1659x2212px; camera: Remidio smartphone fundus camera
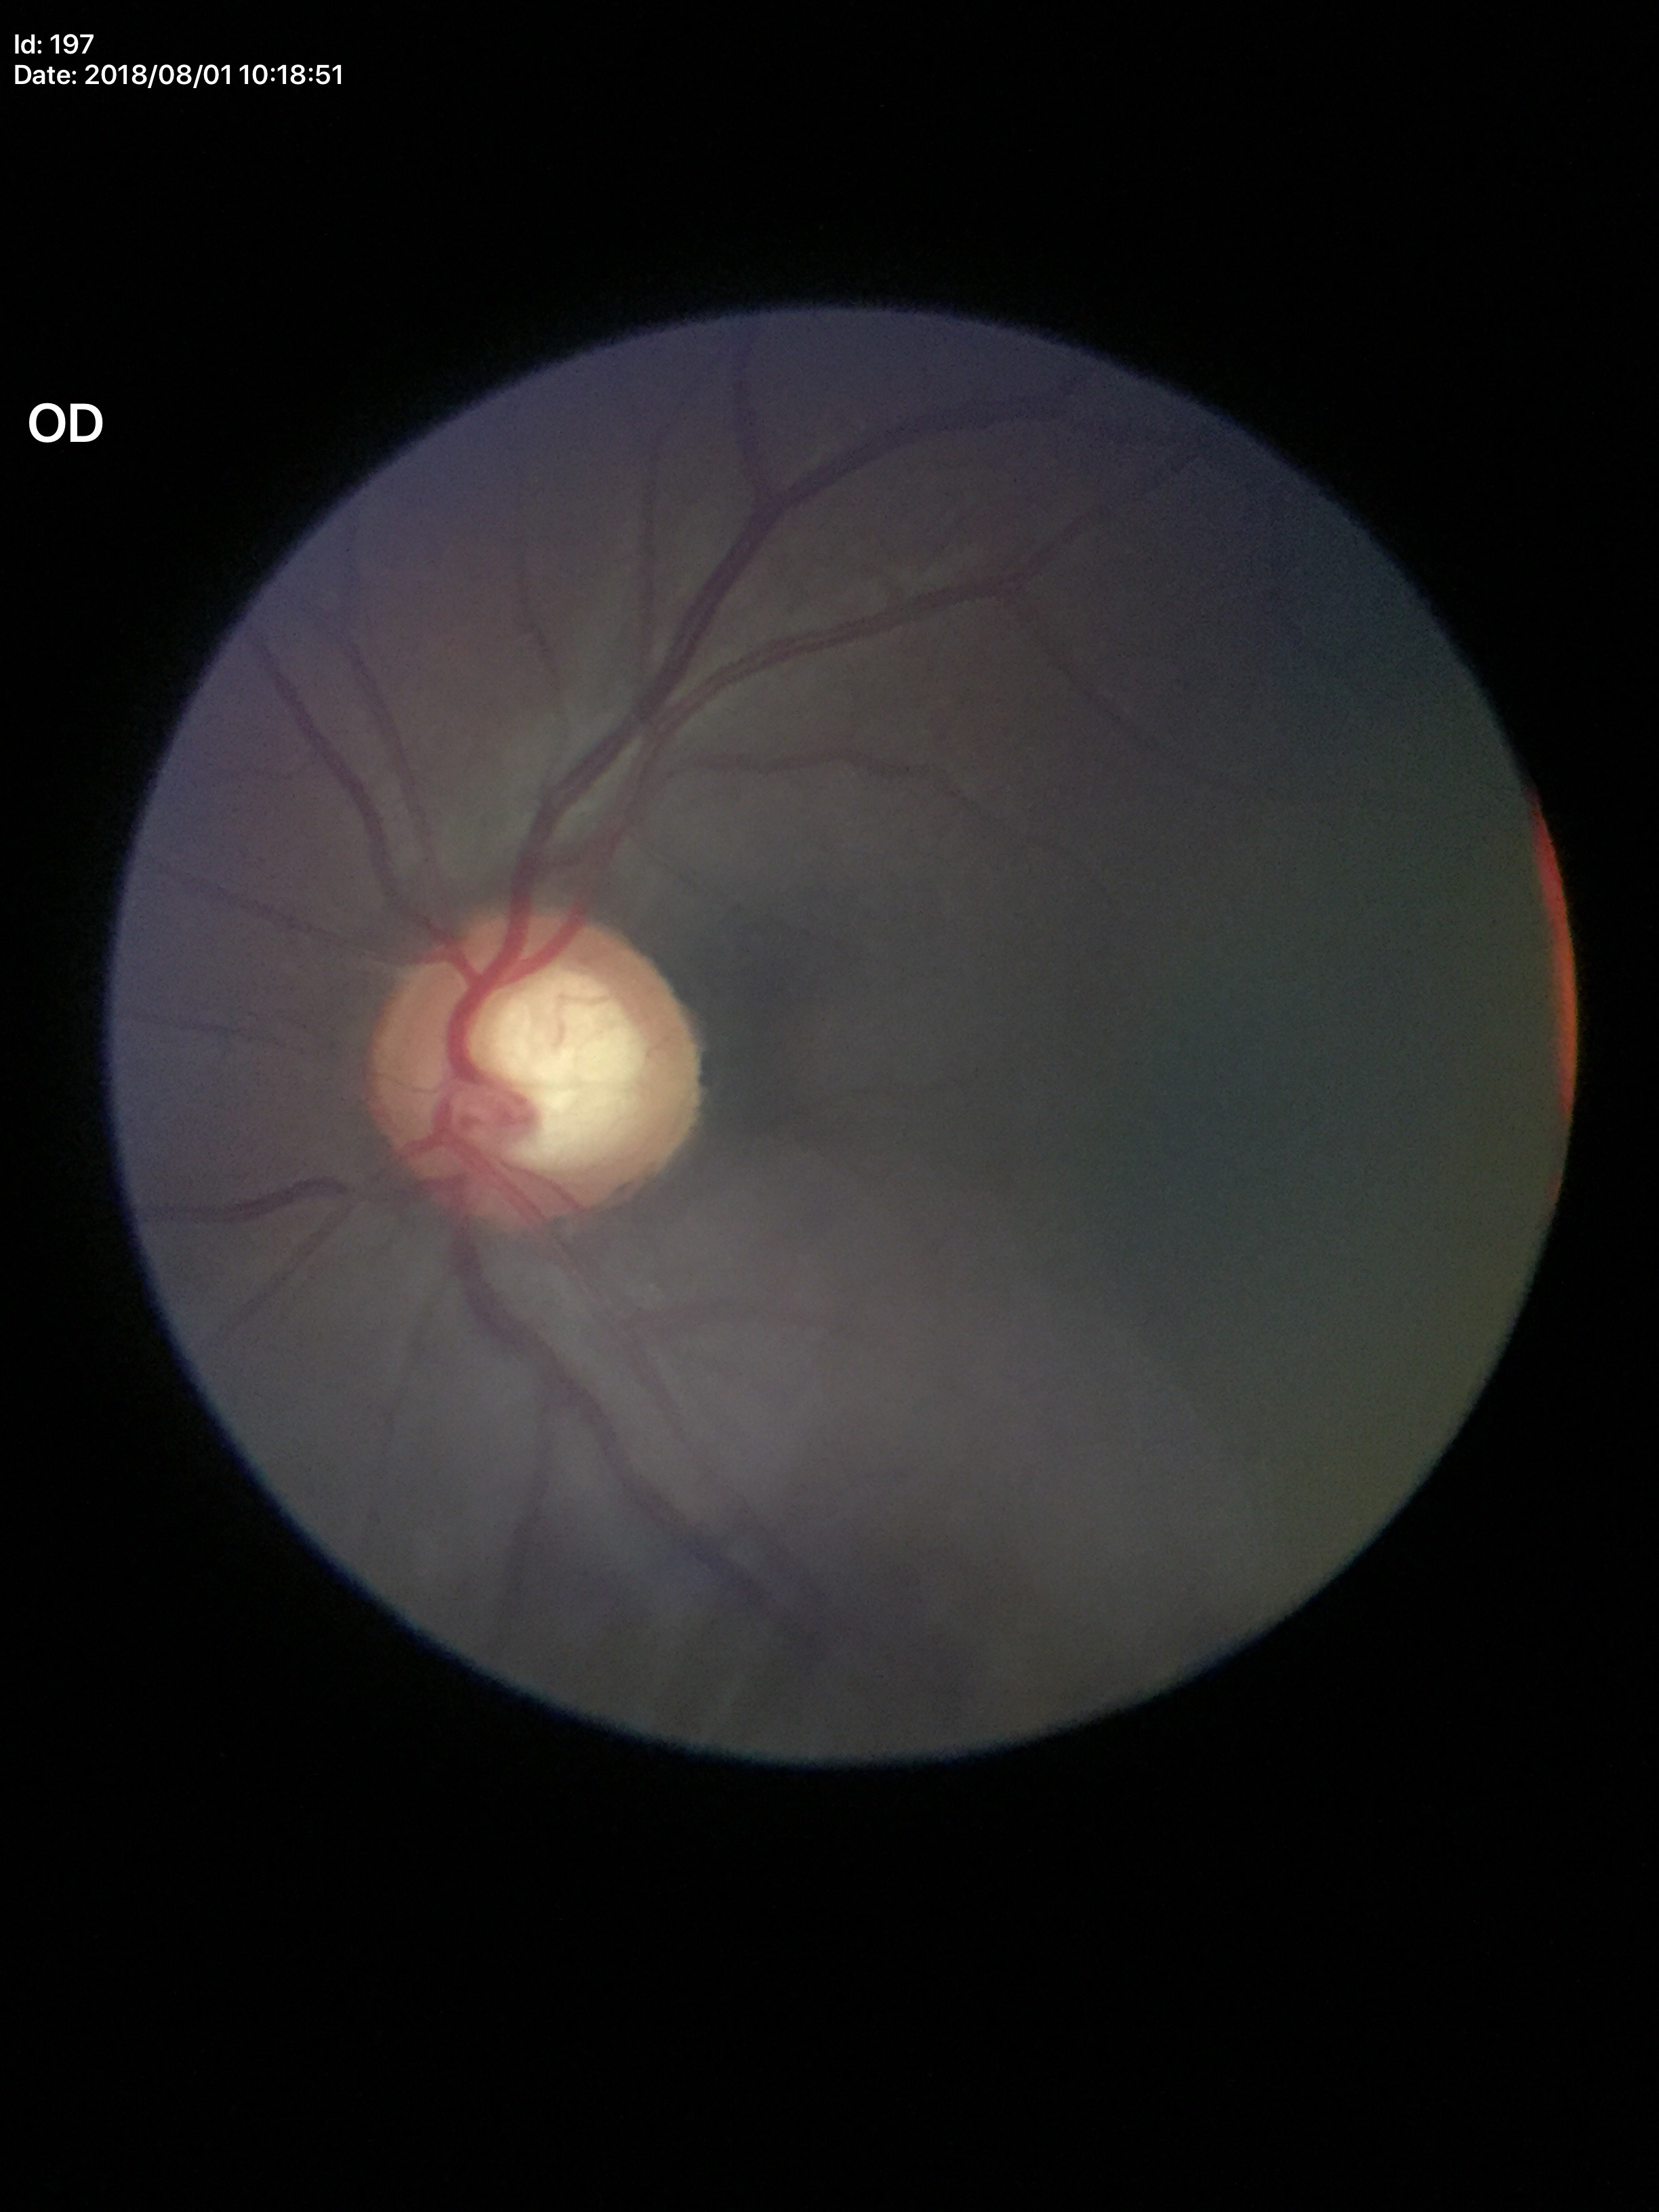 horizontal cup-disc ratio=0.61
Glaucoma evaluation=suspicious (3/5 graders called glaucoma suspect)
vertical C/D ratio=0.62